CFP:
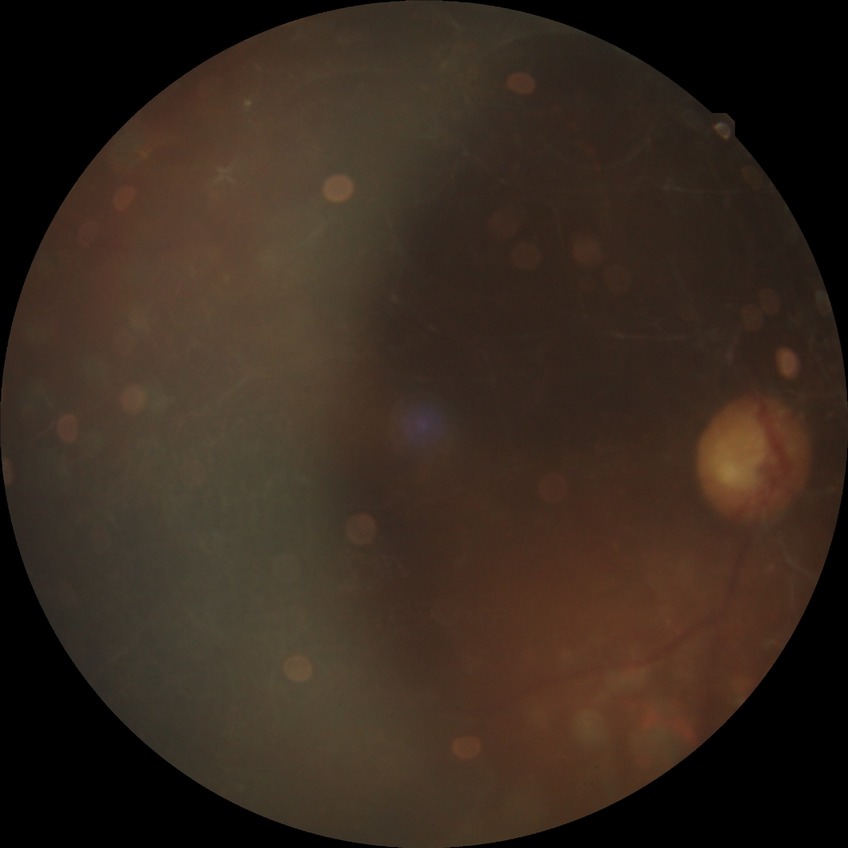

Diabetic retinopathy (DR) is PDR (proliferative diabetic retinopathy).